Phoenix ICON wide-field infant fundus image. Phoenix ICON, 100° FOV:
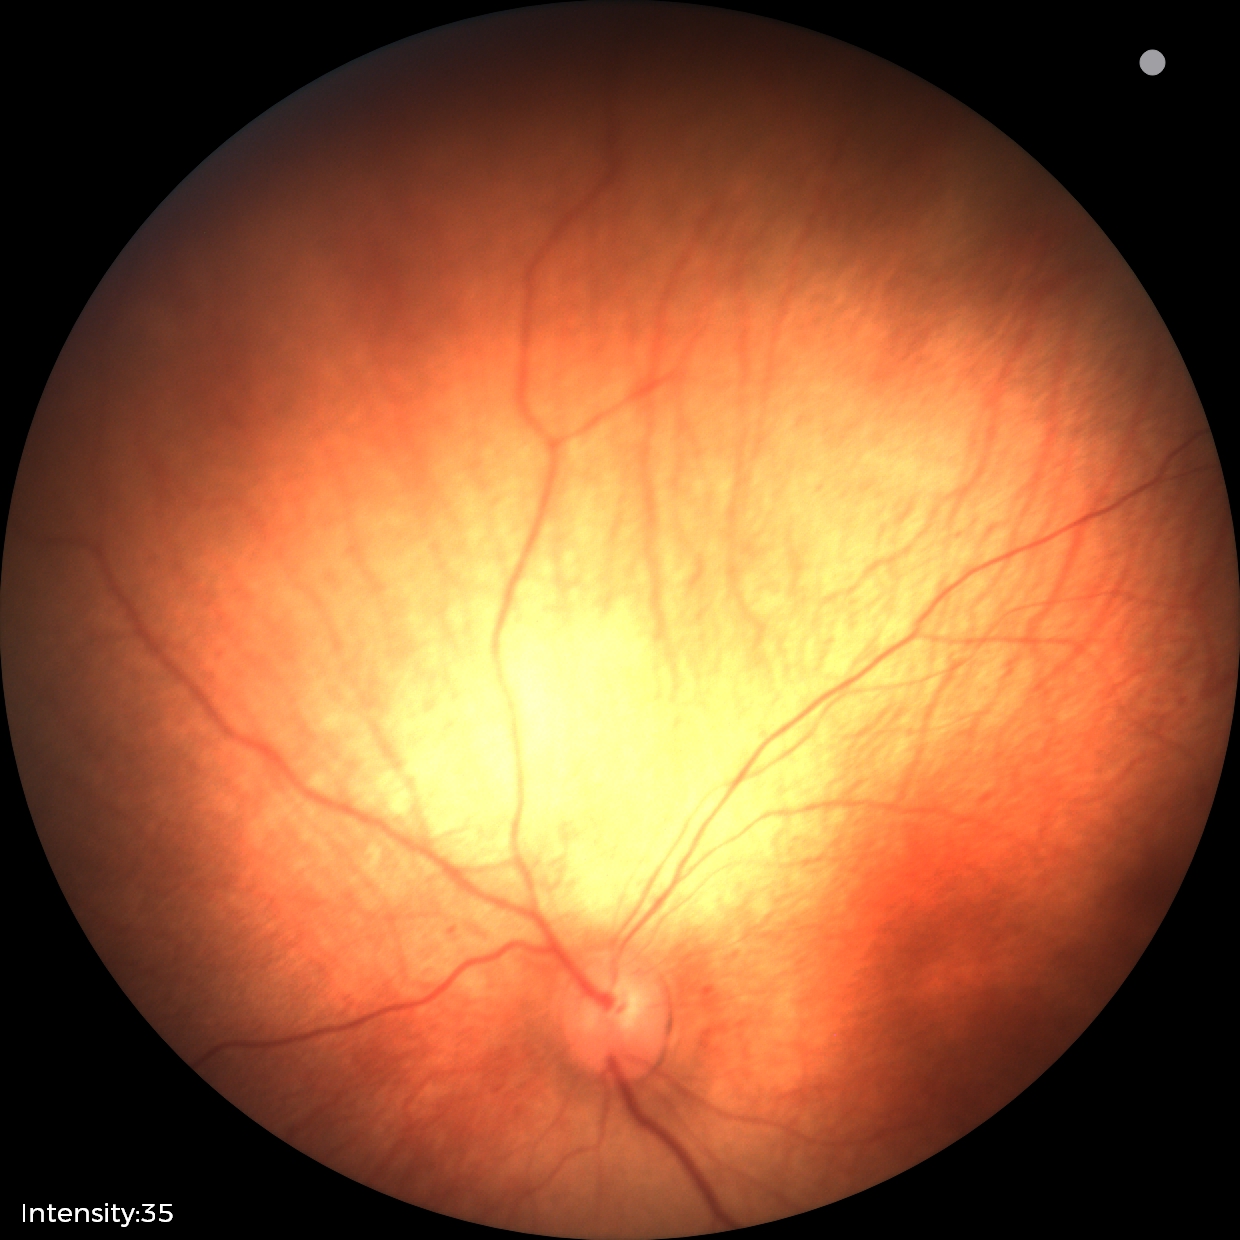 No retinal pathology identified on screening.